45-degree field of view, camera: NIDEK AFC-230, 848x848px, retinal fundus photograph — 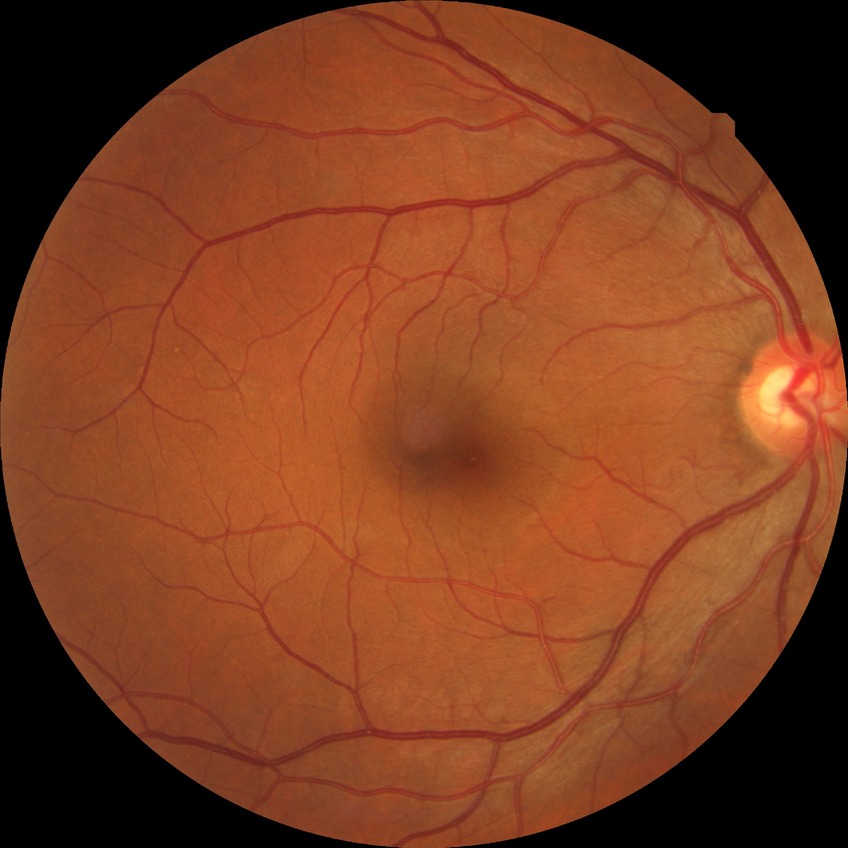
Davis stage: NDR.